45° field of view.
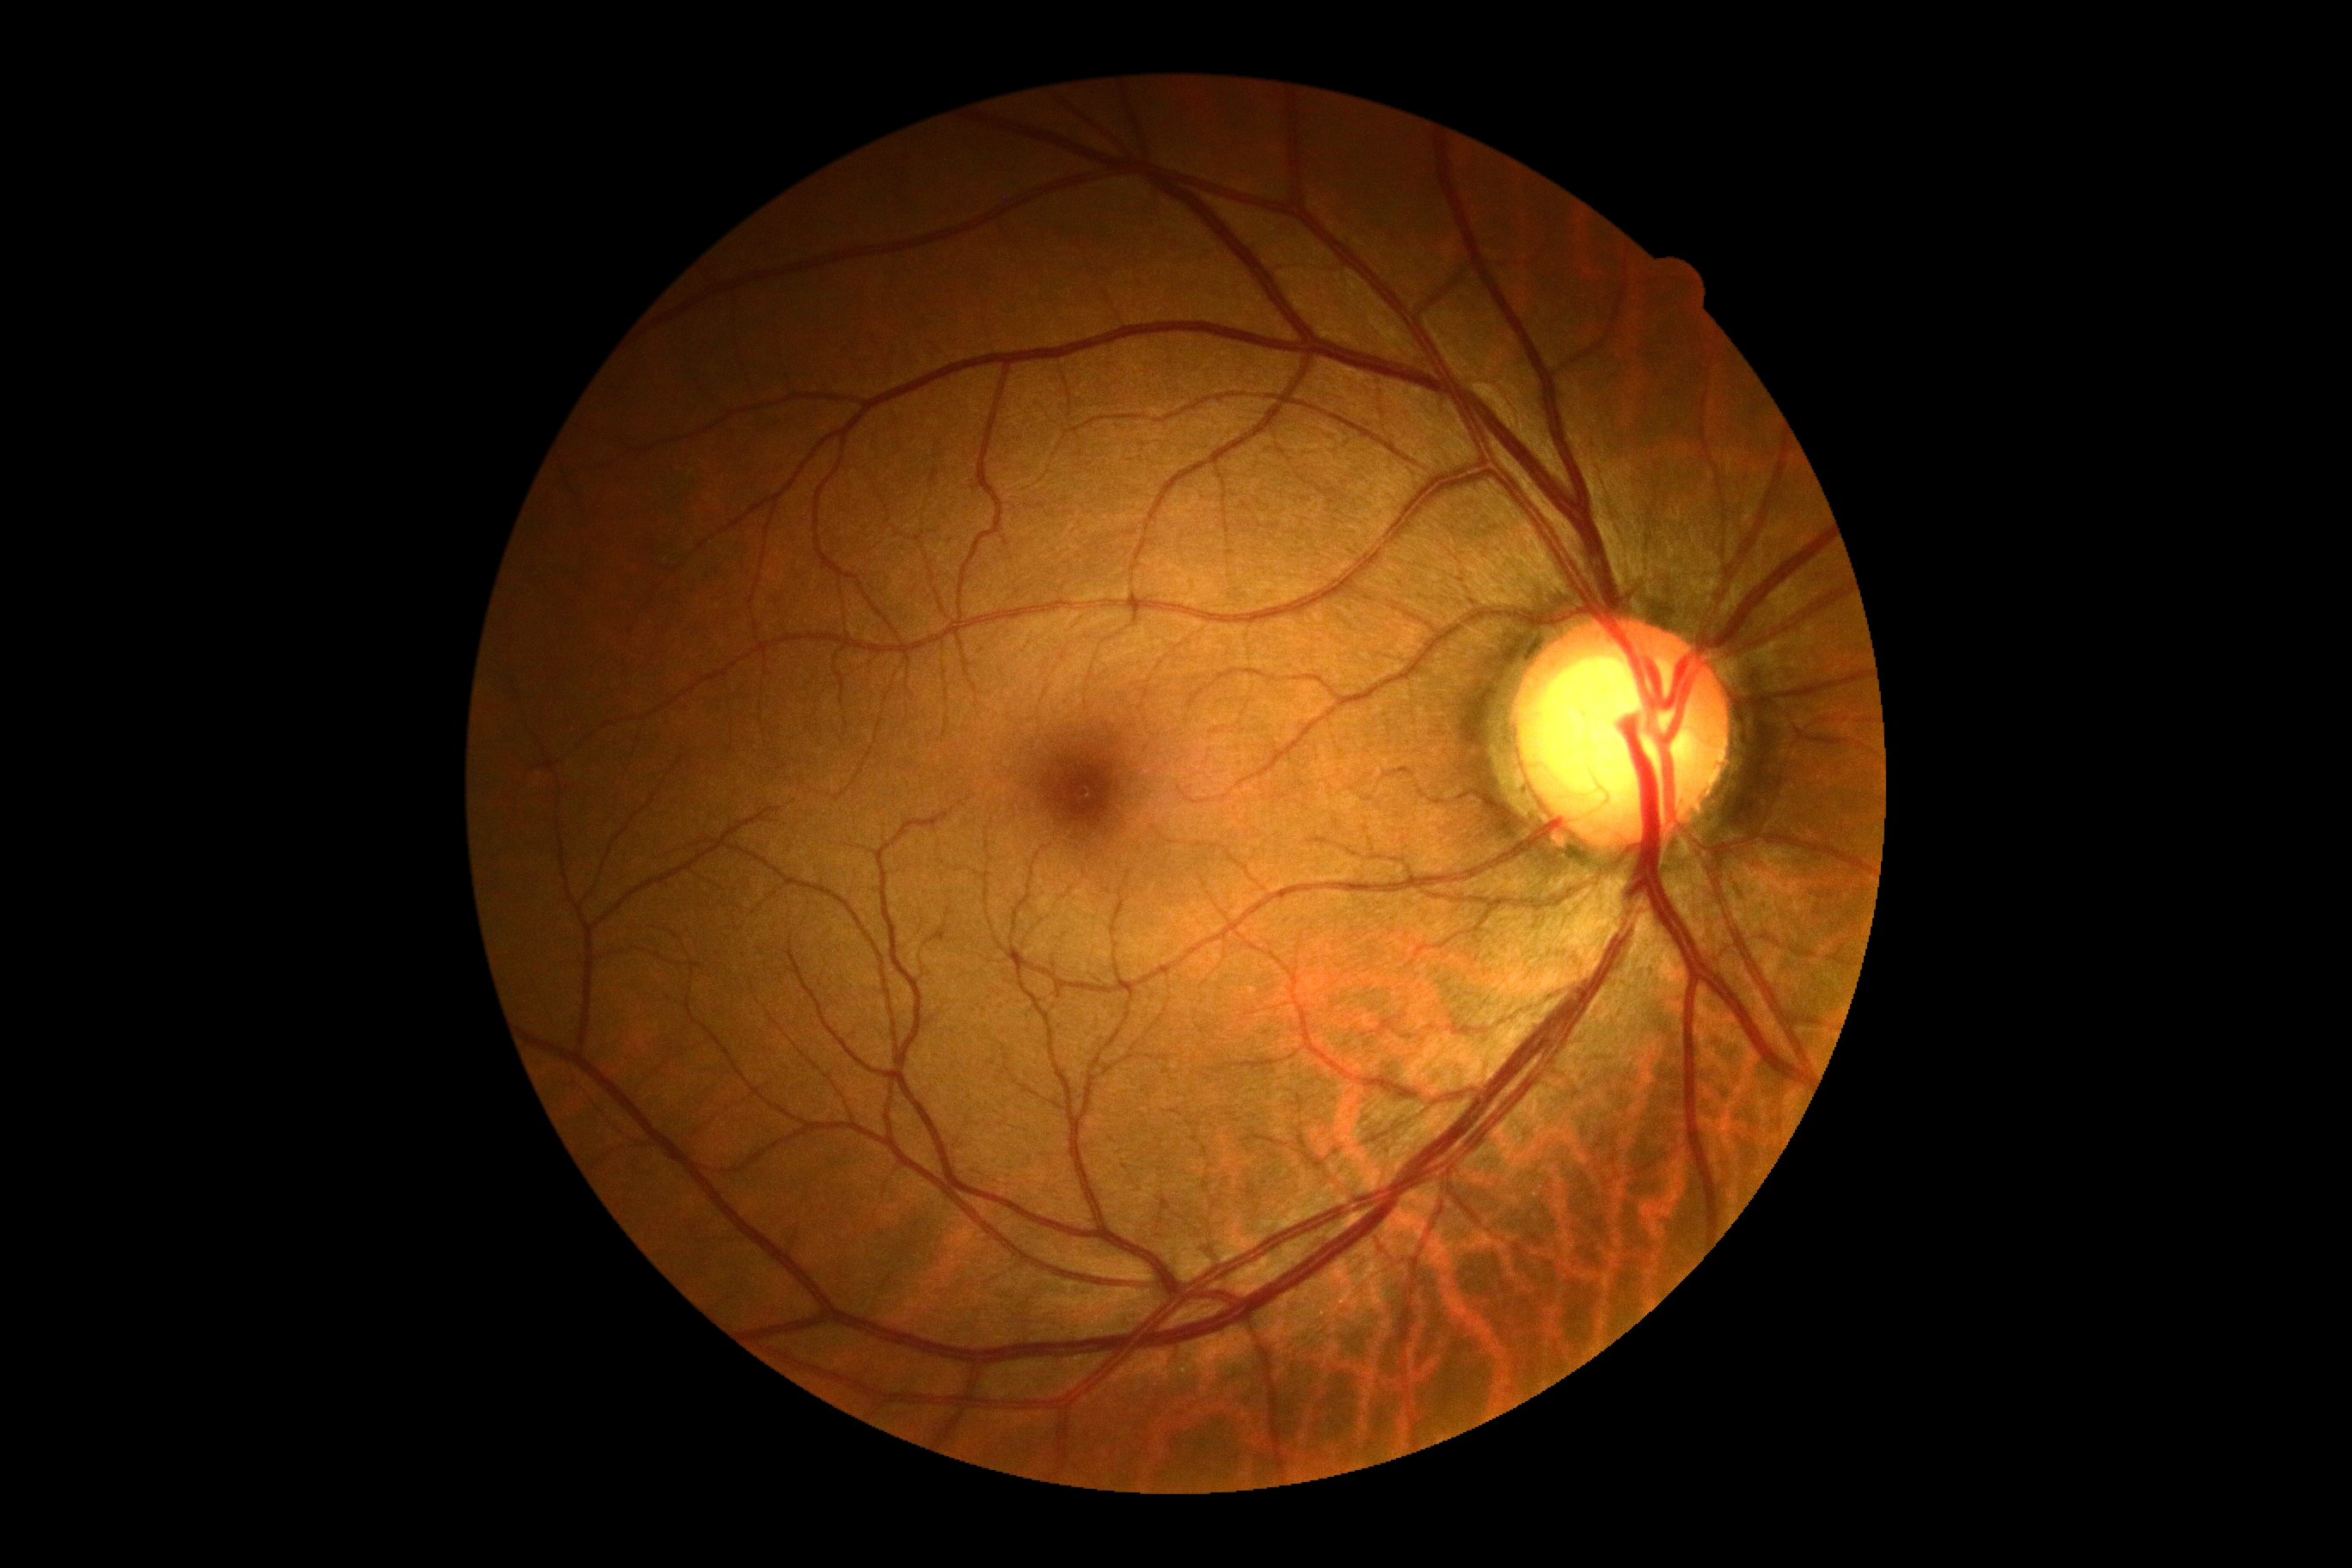 No DR findings. DR: grade 0 (no apparent retinopathy) — no visible signs of diabetic retinopathy.